1240x1240. Phoenix ICON, 100° FOV. Pediatric retinal photograph (wide-field):
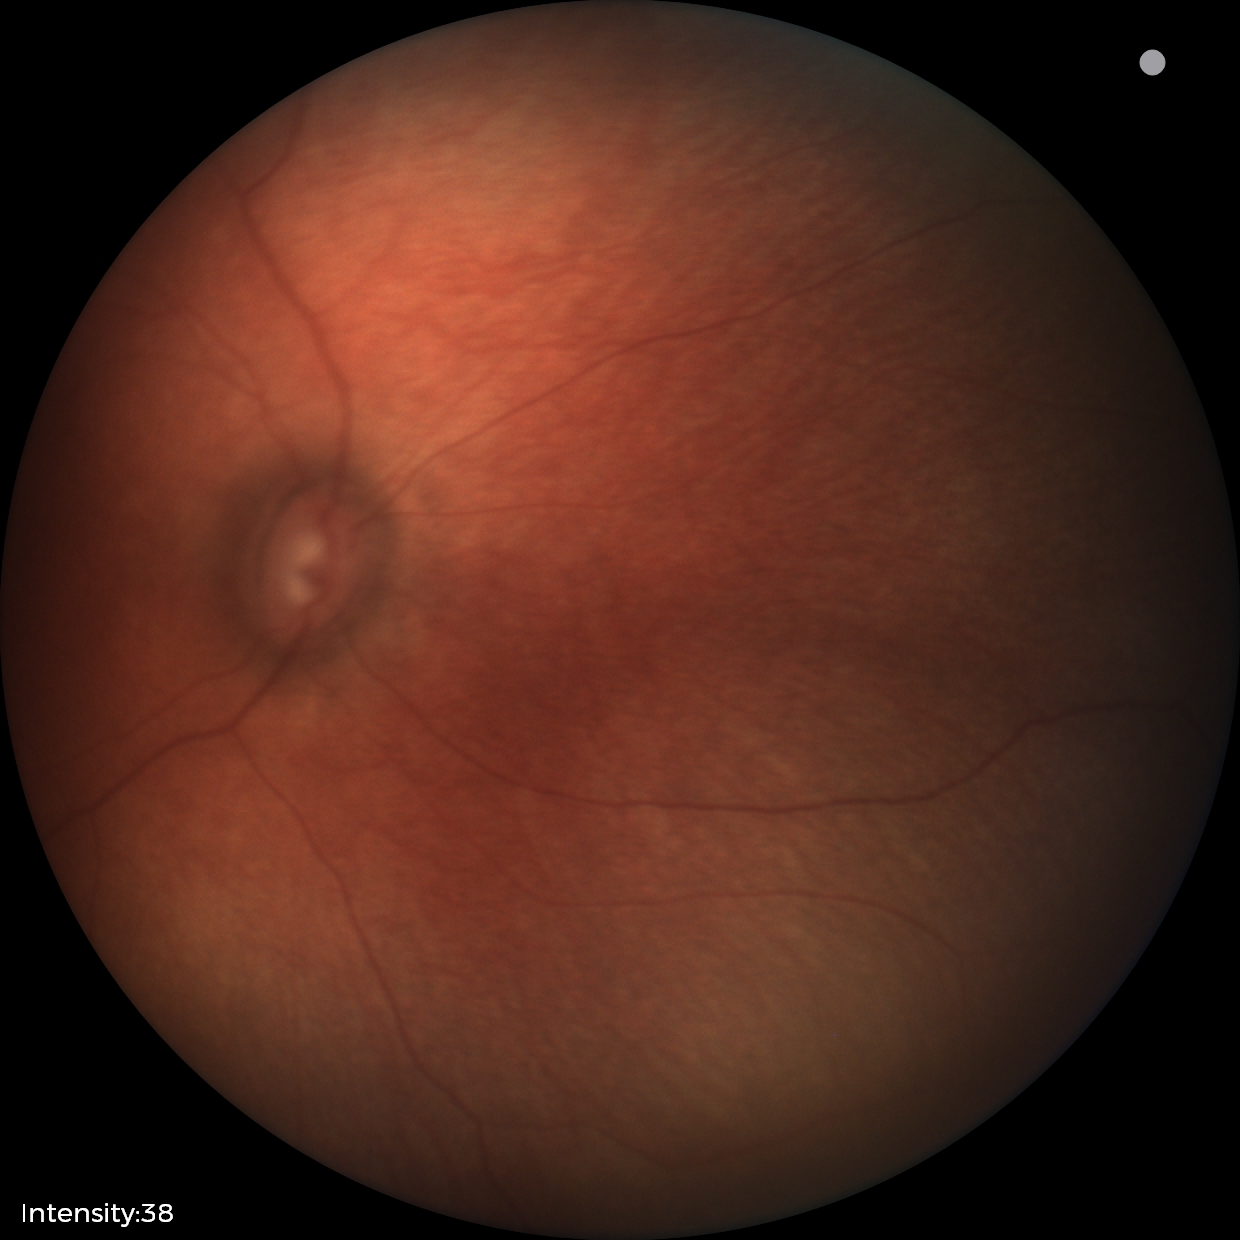 Screening examination diagnosed as physiological.